30° FOV. Patient age: 61 years. Pachymetry: 549 µm. Axial length (AL): 22.6 mm. 2212x1661. Optic disc at the center of the field. Sex: M. Fundus photo. Refraction: +1.5 -0.75 x 30. Intraocular pressure 17 mmHg by non-contact tonometry:
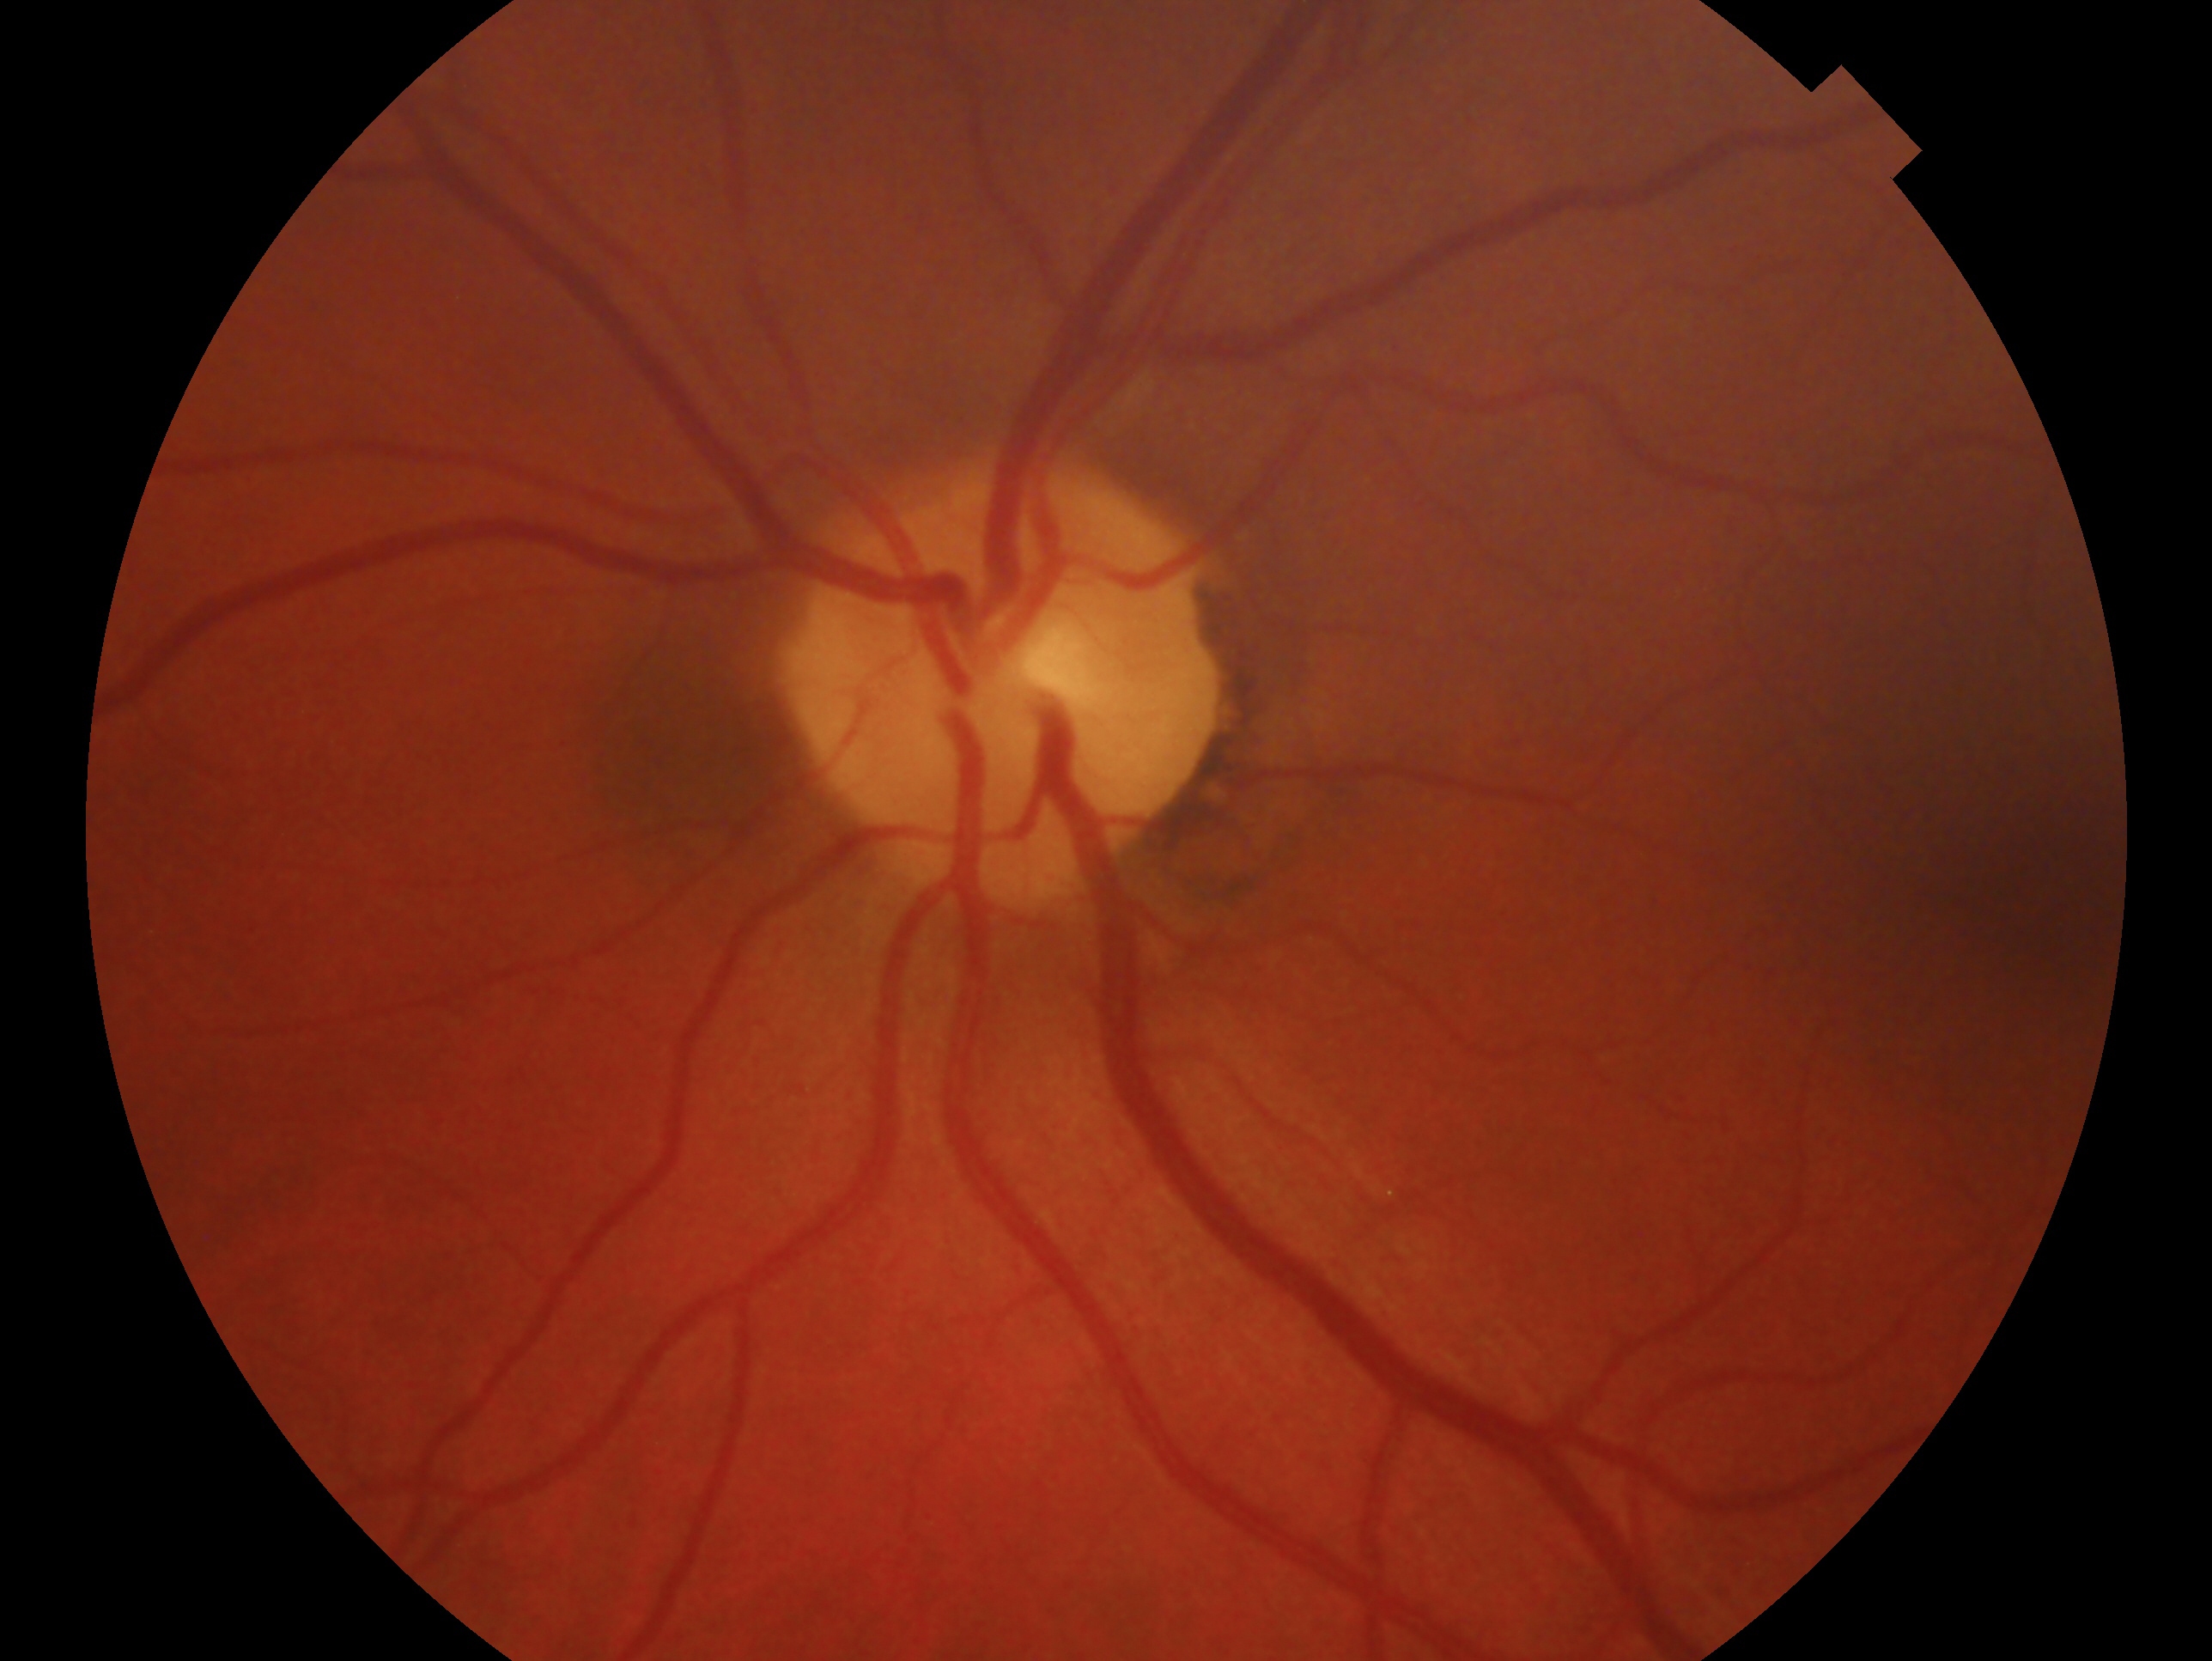

• eye: OS
• assessment: negative for glaucoma